640x480. Infant wide-field retinal image
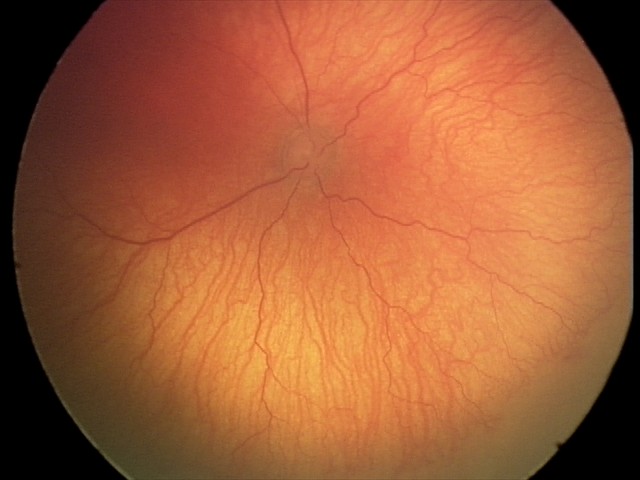

Assessment = aggressive retinopathy of prematurity (A-ROP).